Without pupil dilation; NIDEK AFC-230 fundus camera.
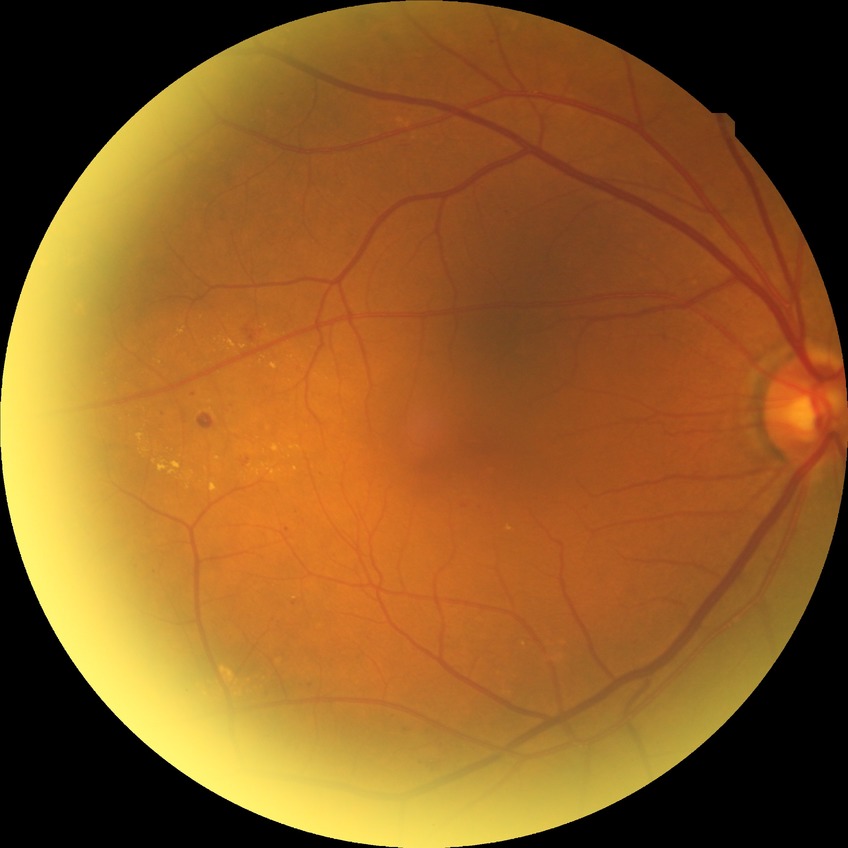 Retinopathy grade: simple diabetic retinopathy.
Disease class: non-proliferative diabetic retinopathy.